Nidek AFC-330.
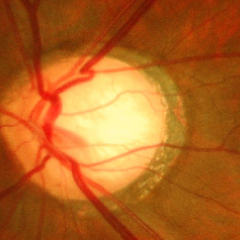
Glaucoma assessment = severe glaucomatous damage. Defined as near-total cupping of the optic nerve head, with or without severe visual field loss within the central 10 degrees of fixation.